Wide-field fundus photograph of an infant. Image size 1240x1240.
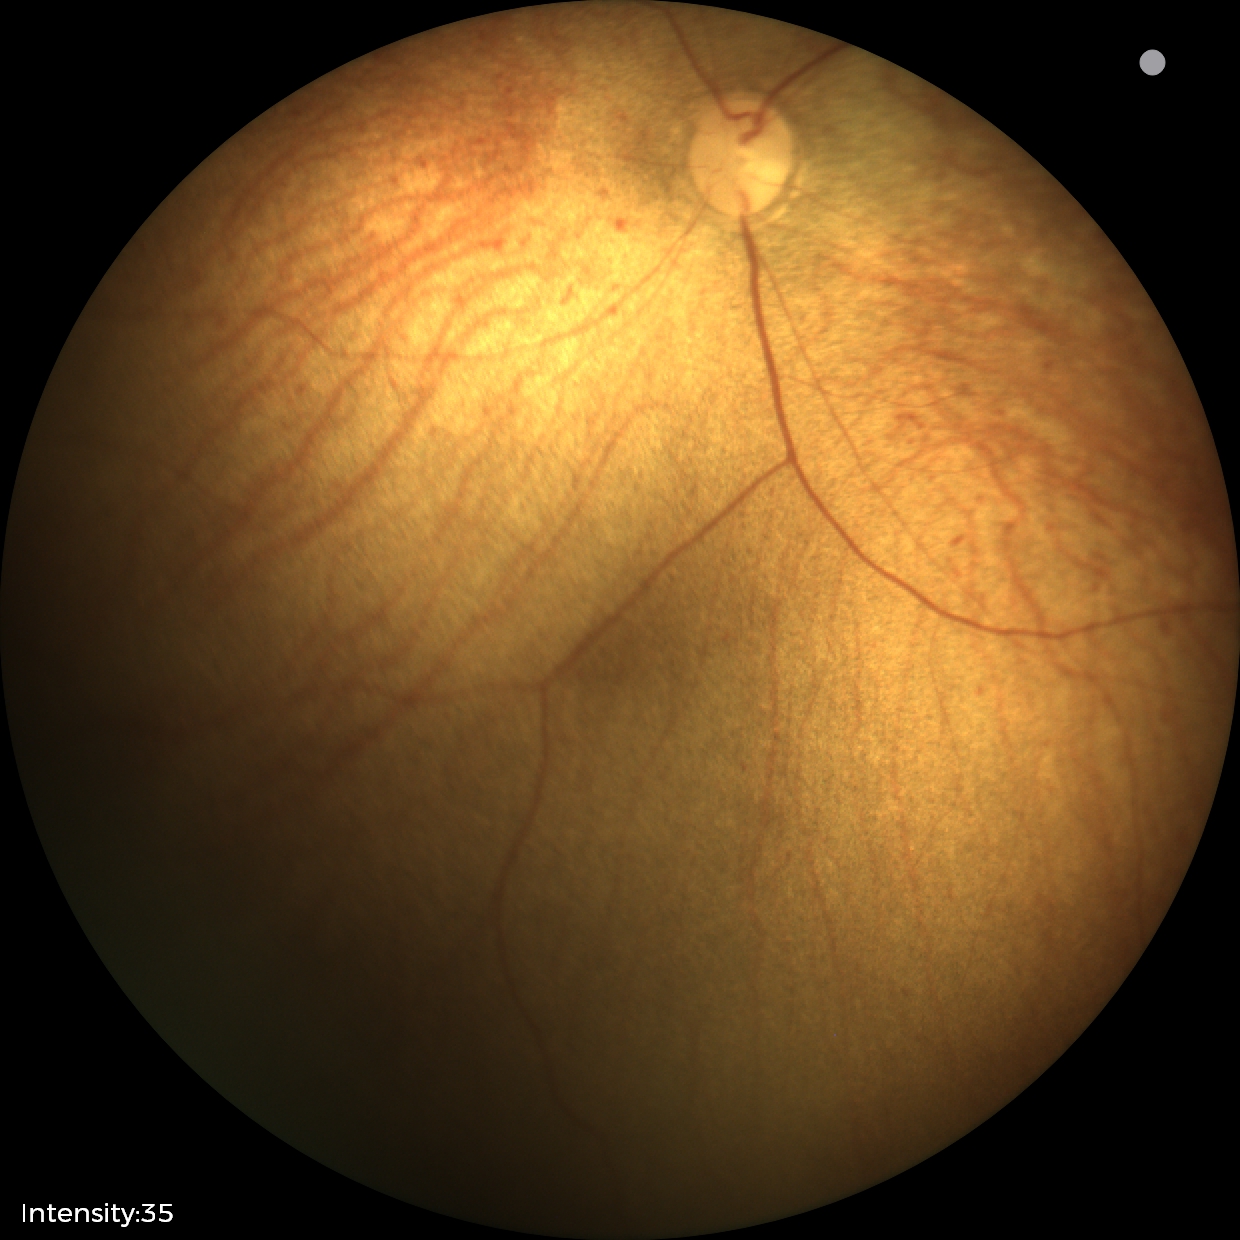 Screening examination diagnosed as physiological.